Wide-field contact fundus photograph of an infant; image size 1440x1080 — 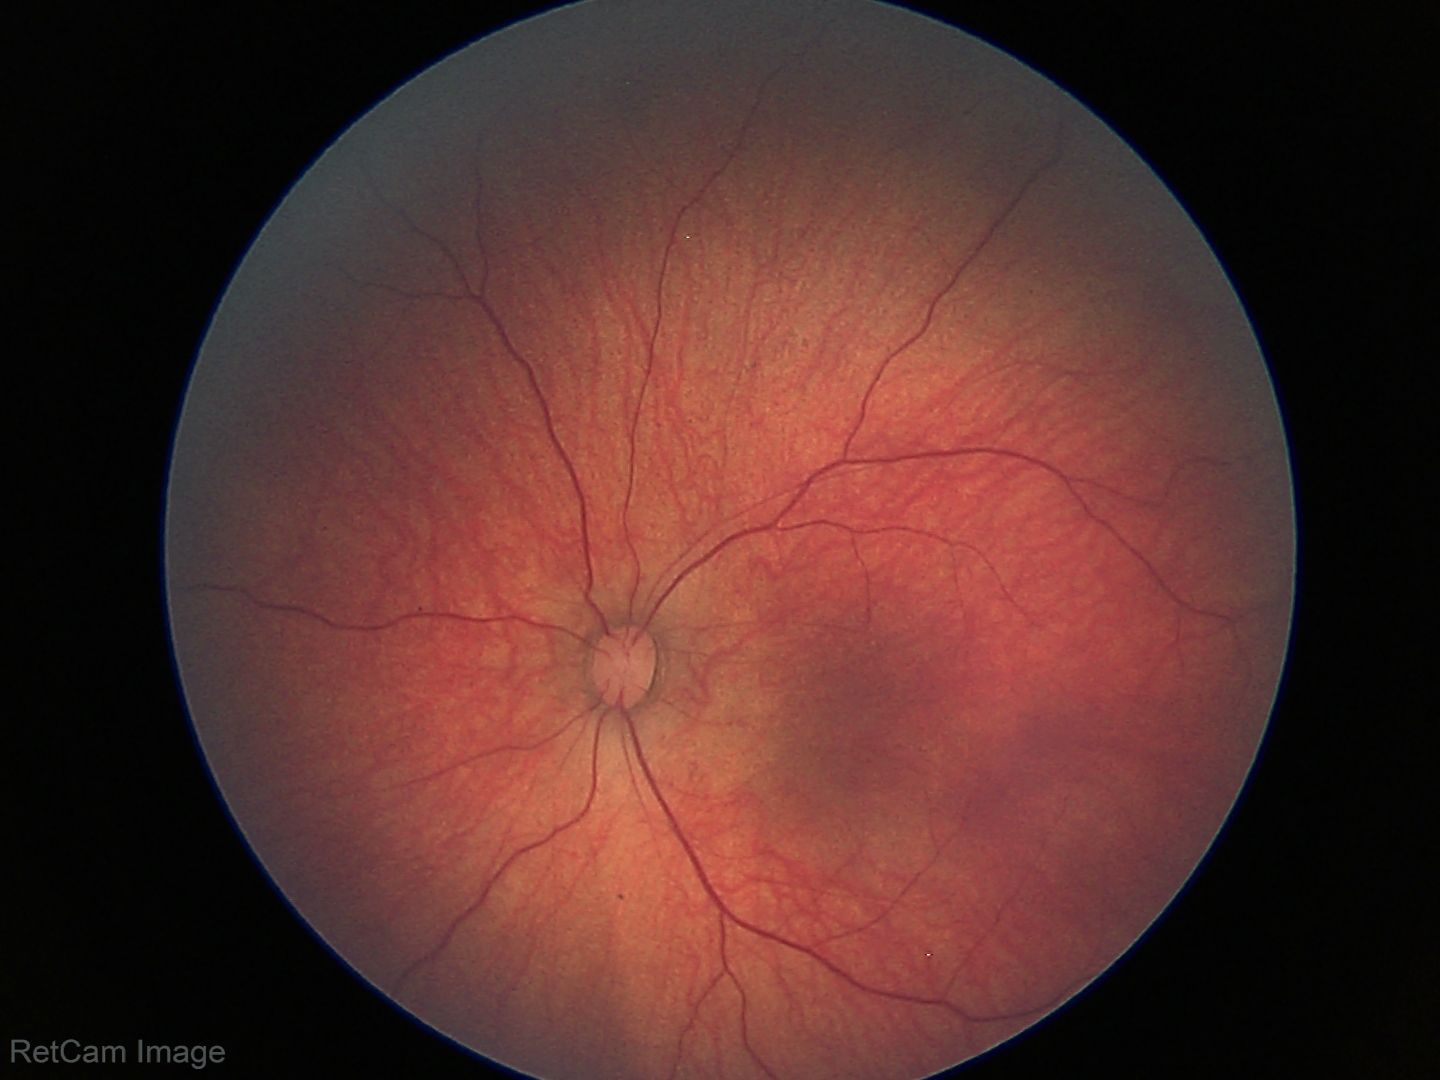 Assessment = retinal hemorrhages.